Tabletop color fundus camera image; 50° FOV; 1924x1556
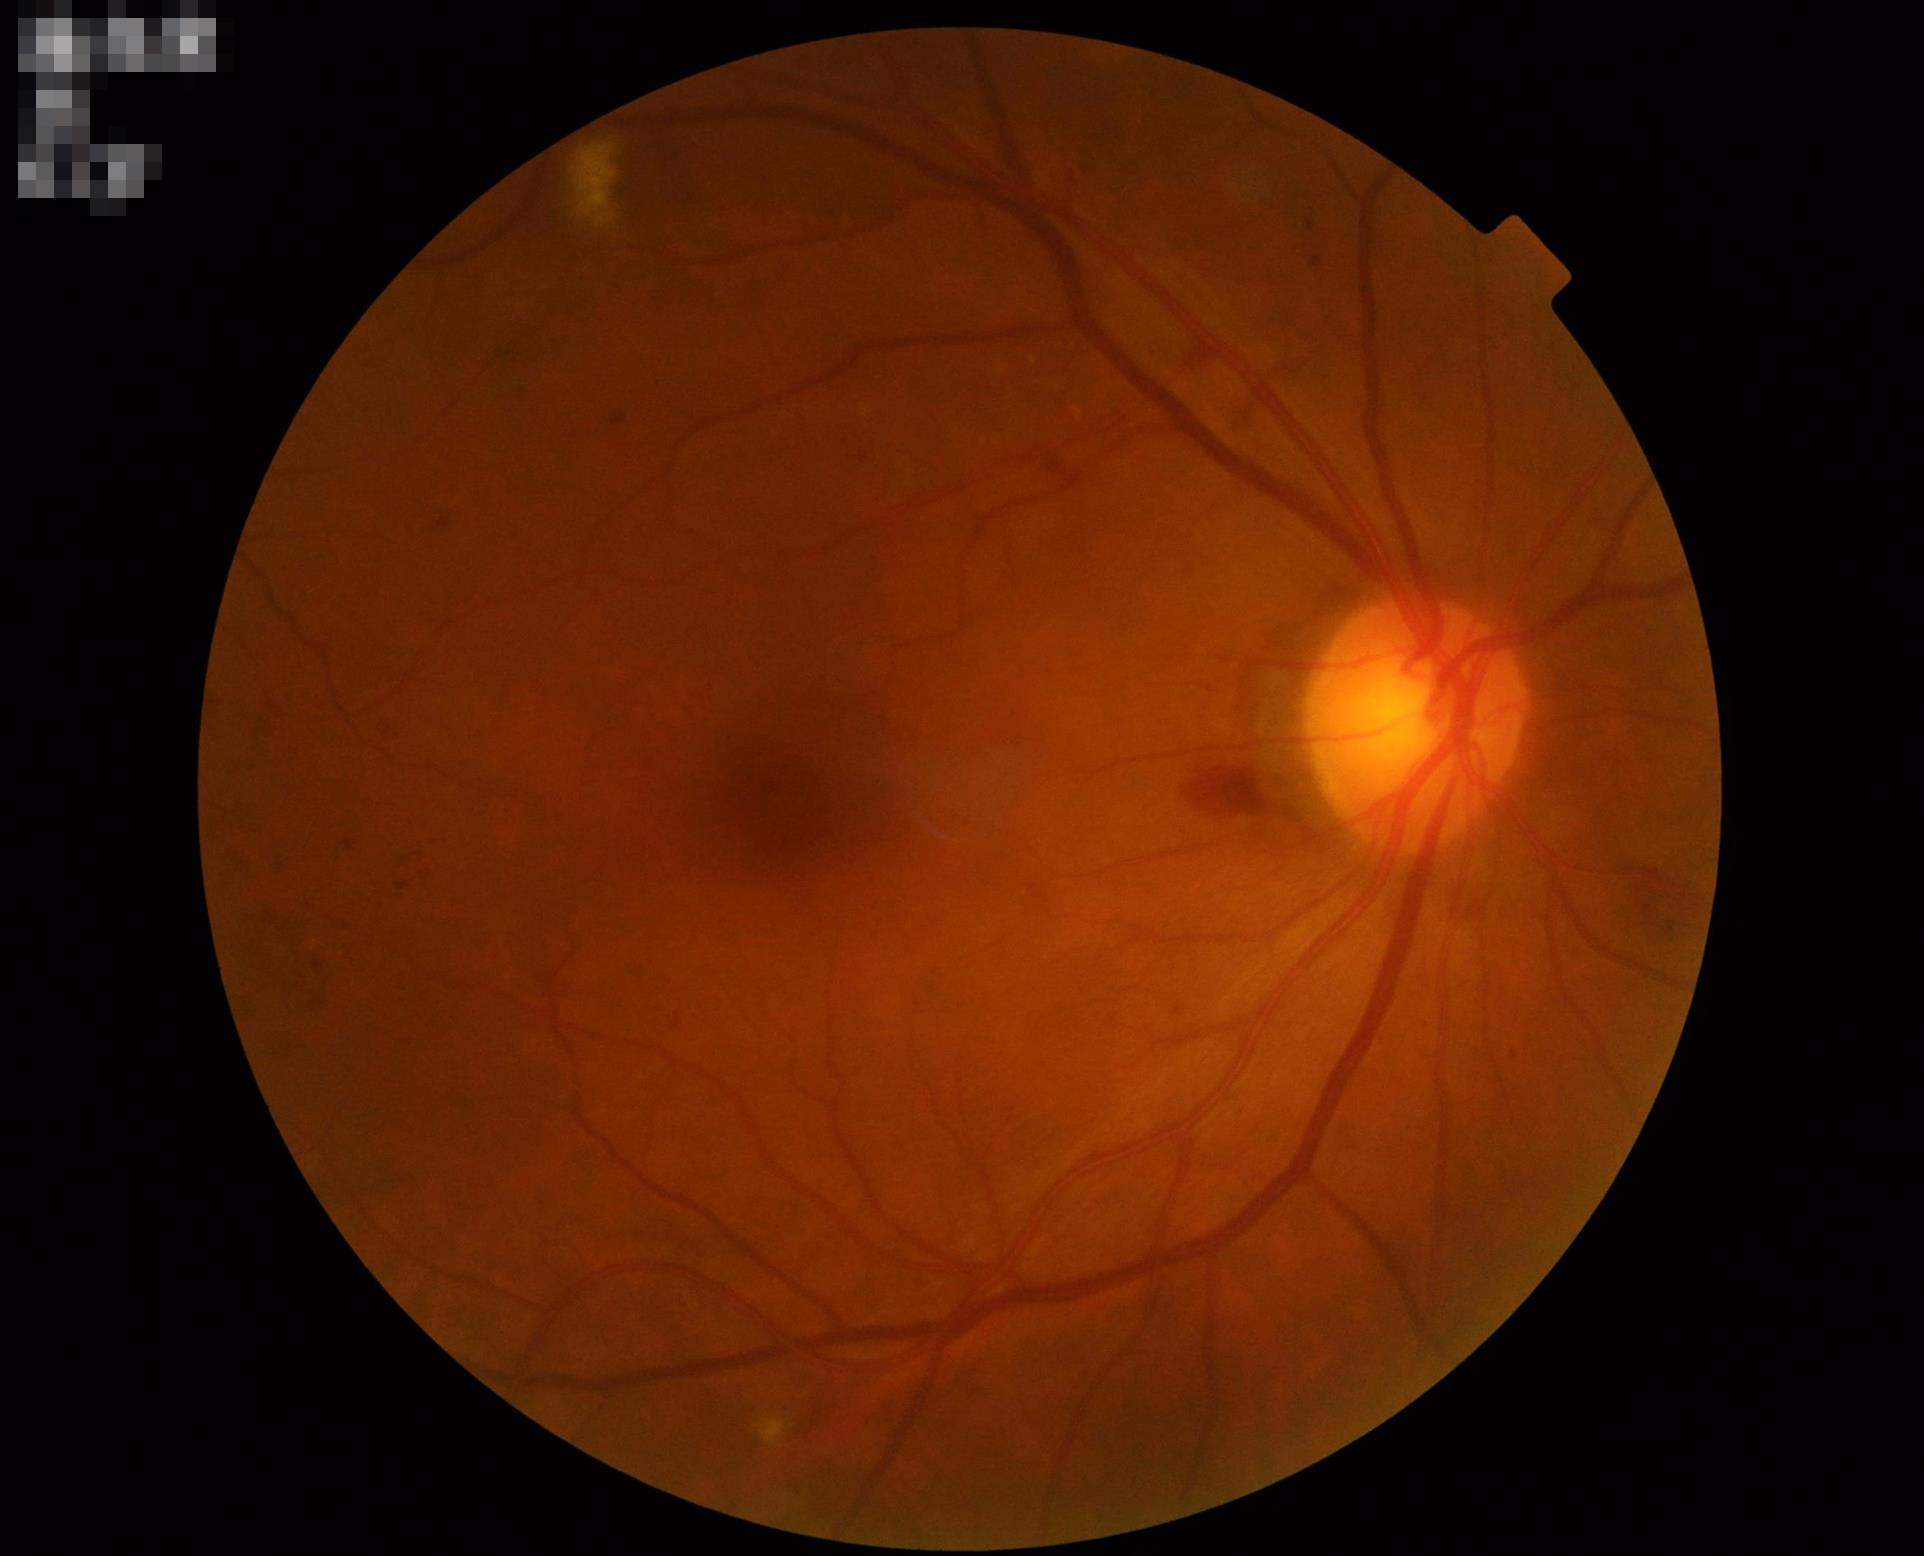

Contrast = good
Overall image quality = satisfactory
Focus = good